Wide-field fundus image from infant ROP screening; camera: Phoenix ICON (100° FOV): 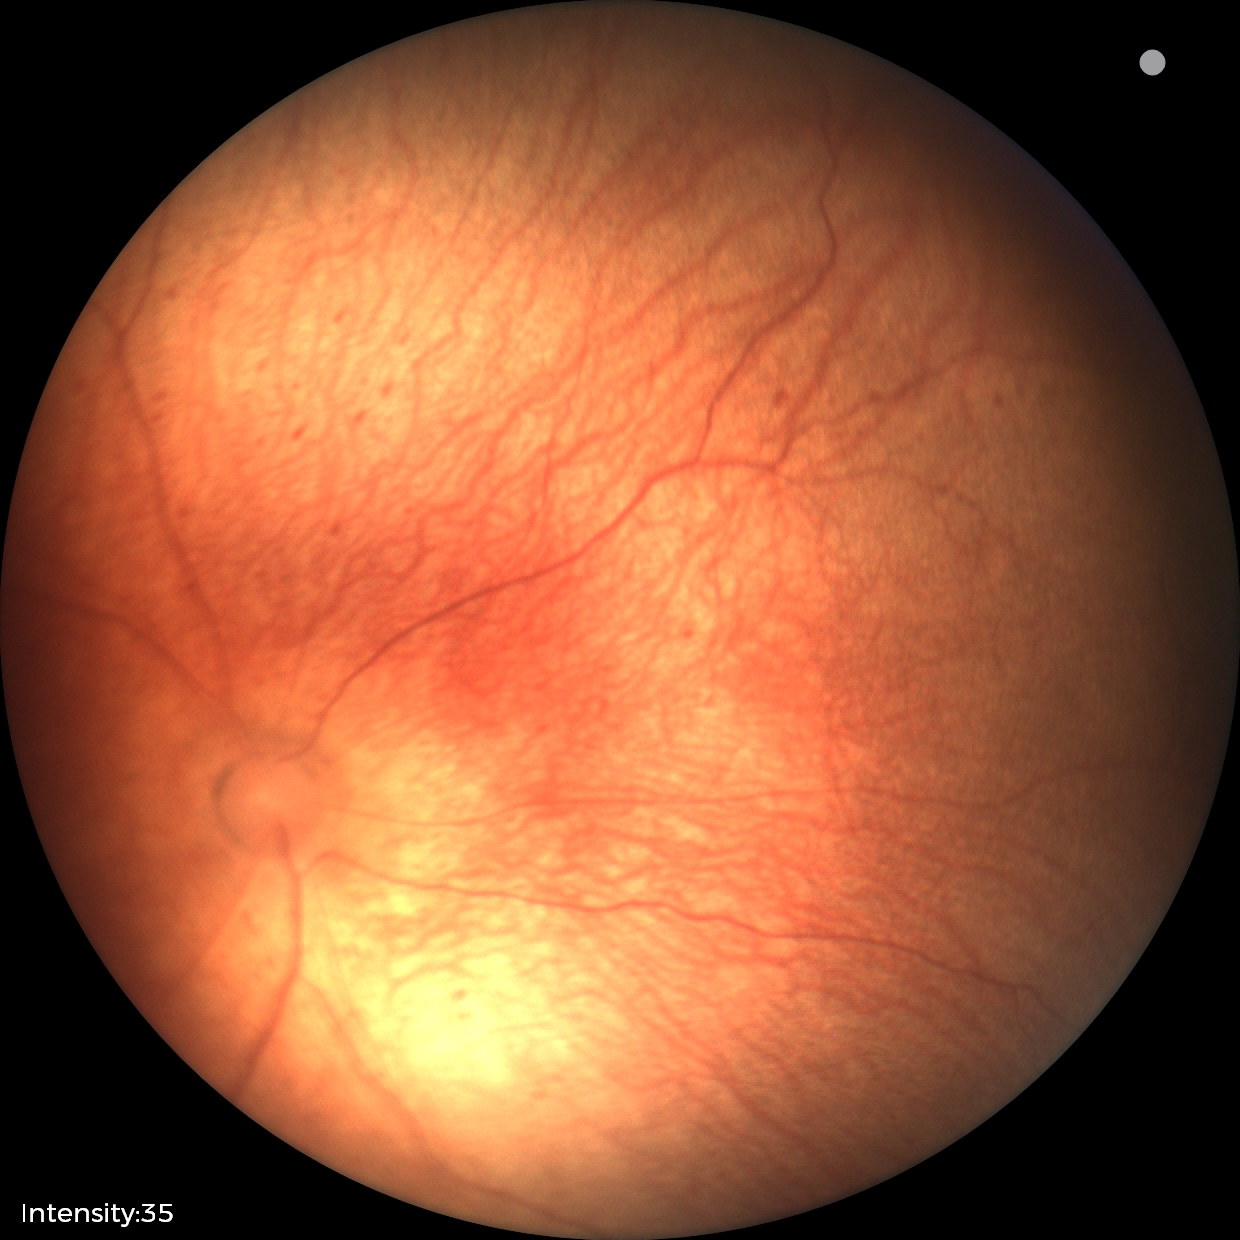 Plus disease absent. Examination diagnosed as status post retinopathy of prematurity (ROP) — retinal appearance after treated retinopathy of prematurity.